Image size 2352x1568: 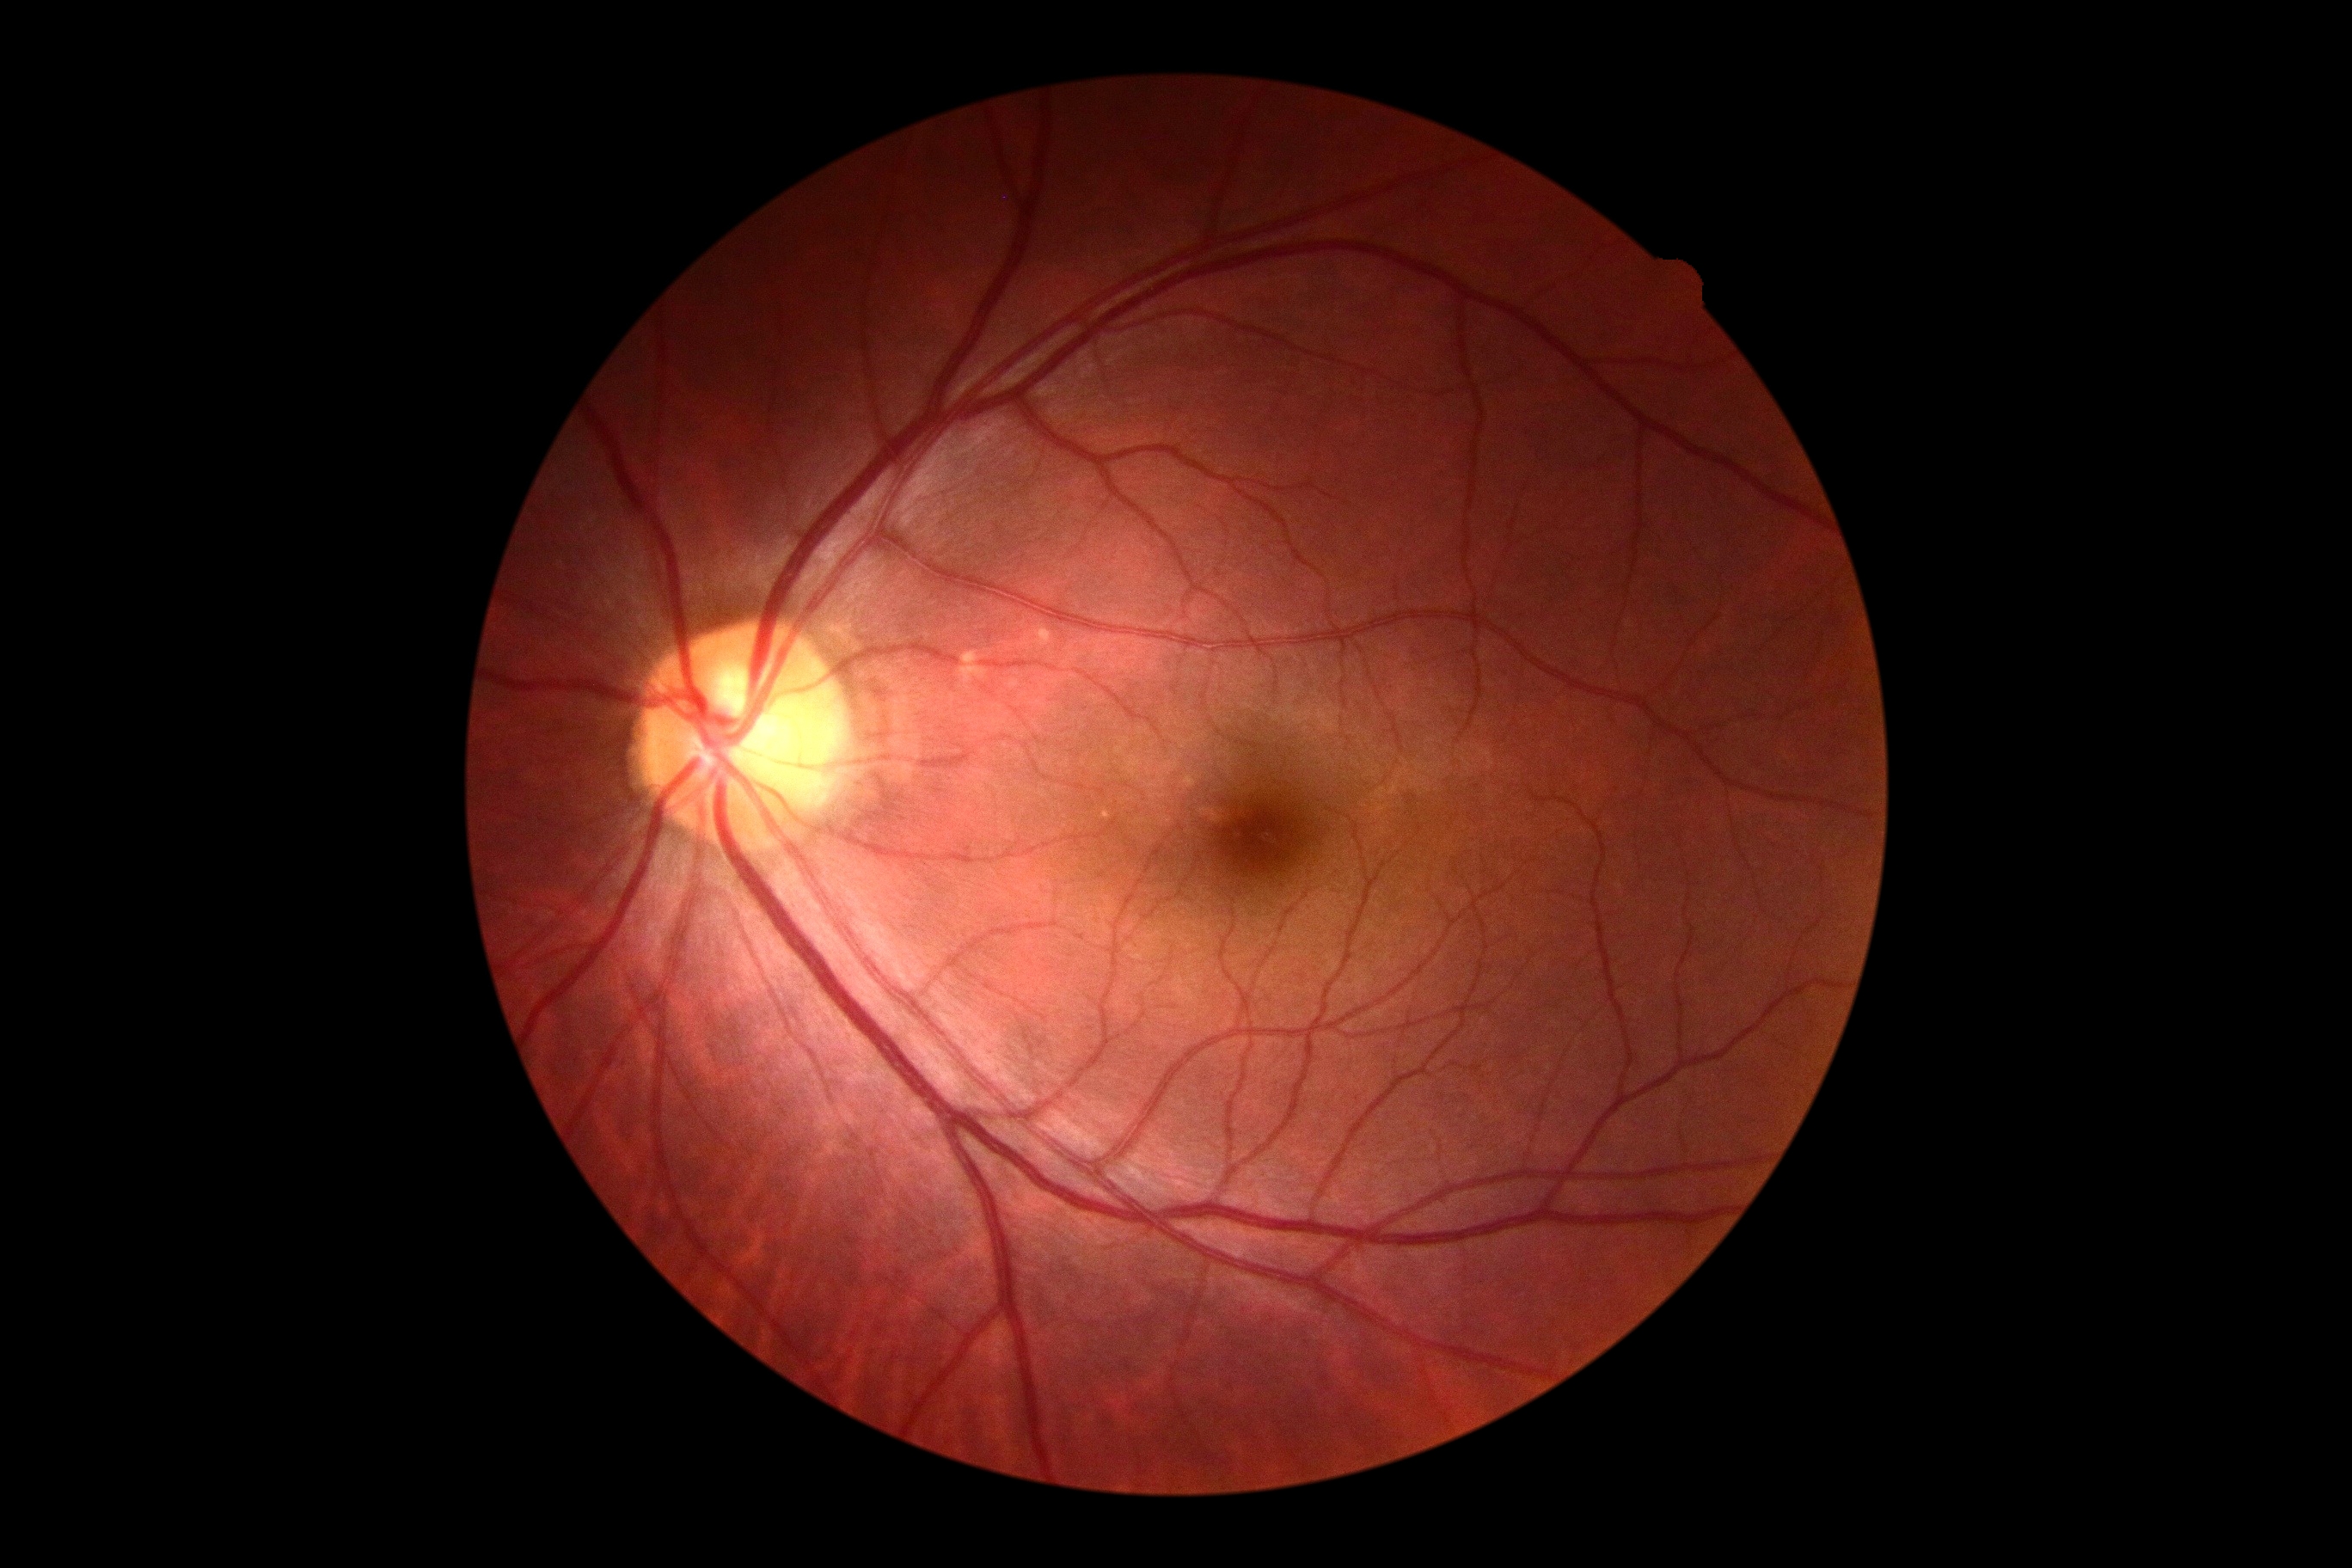 No diabetic retinal disease findings.
Diabetic retinopathy severity is no apparent diabetic retinopathy (grade 0).